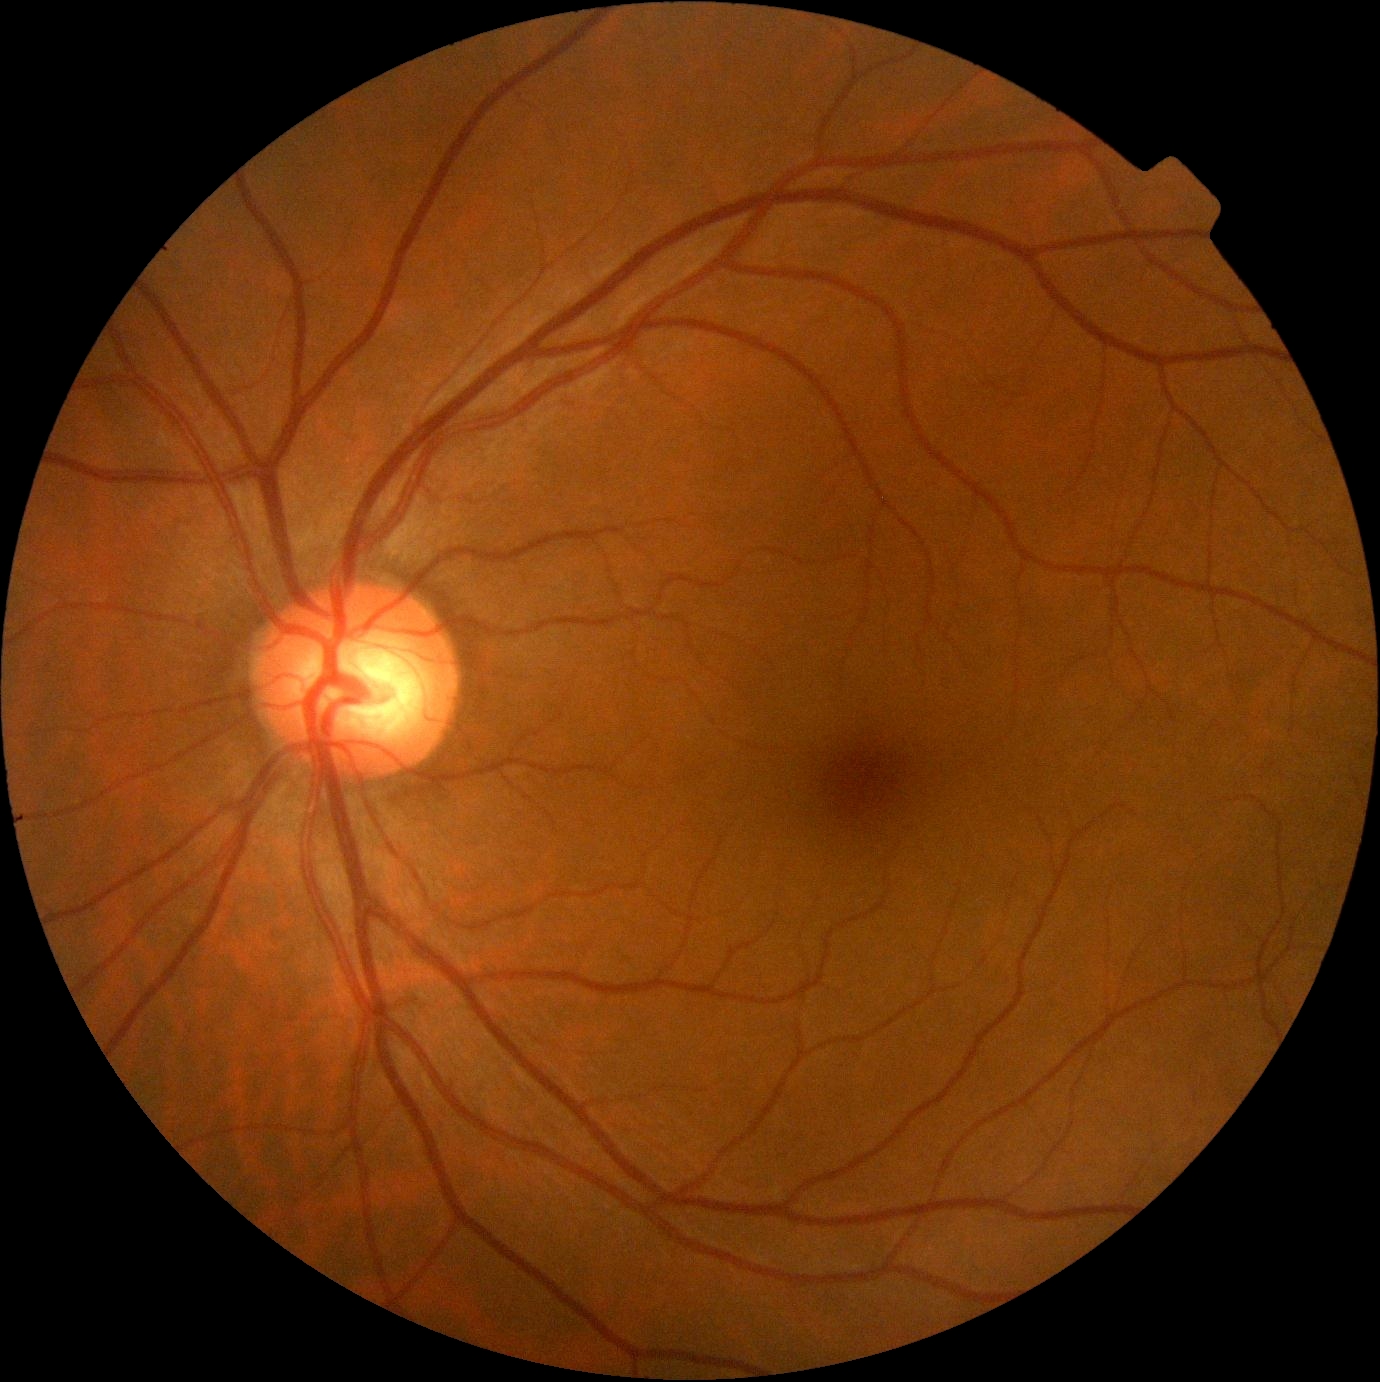 Diabetic retinopathy severity is 0/4. No diabetic retinal disease findings.